Wide-field fundus image from infant ROP screening.
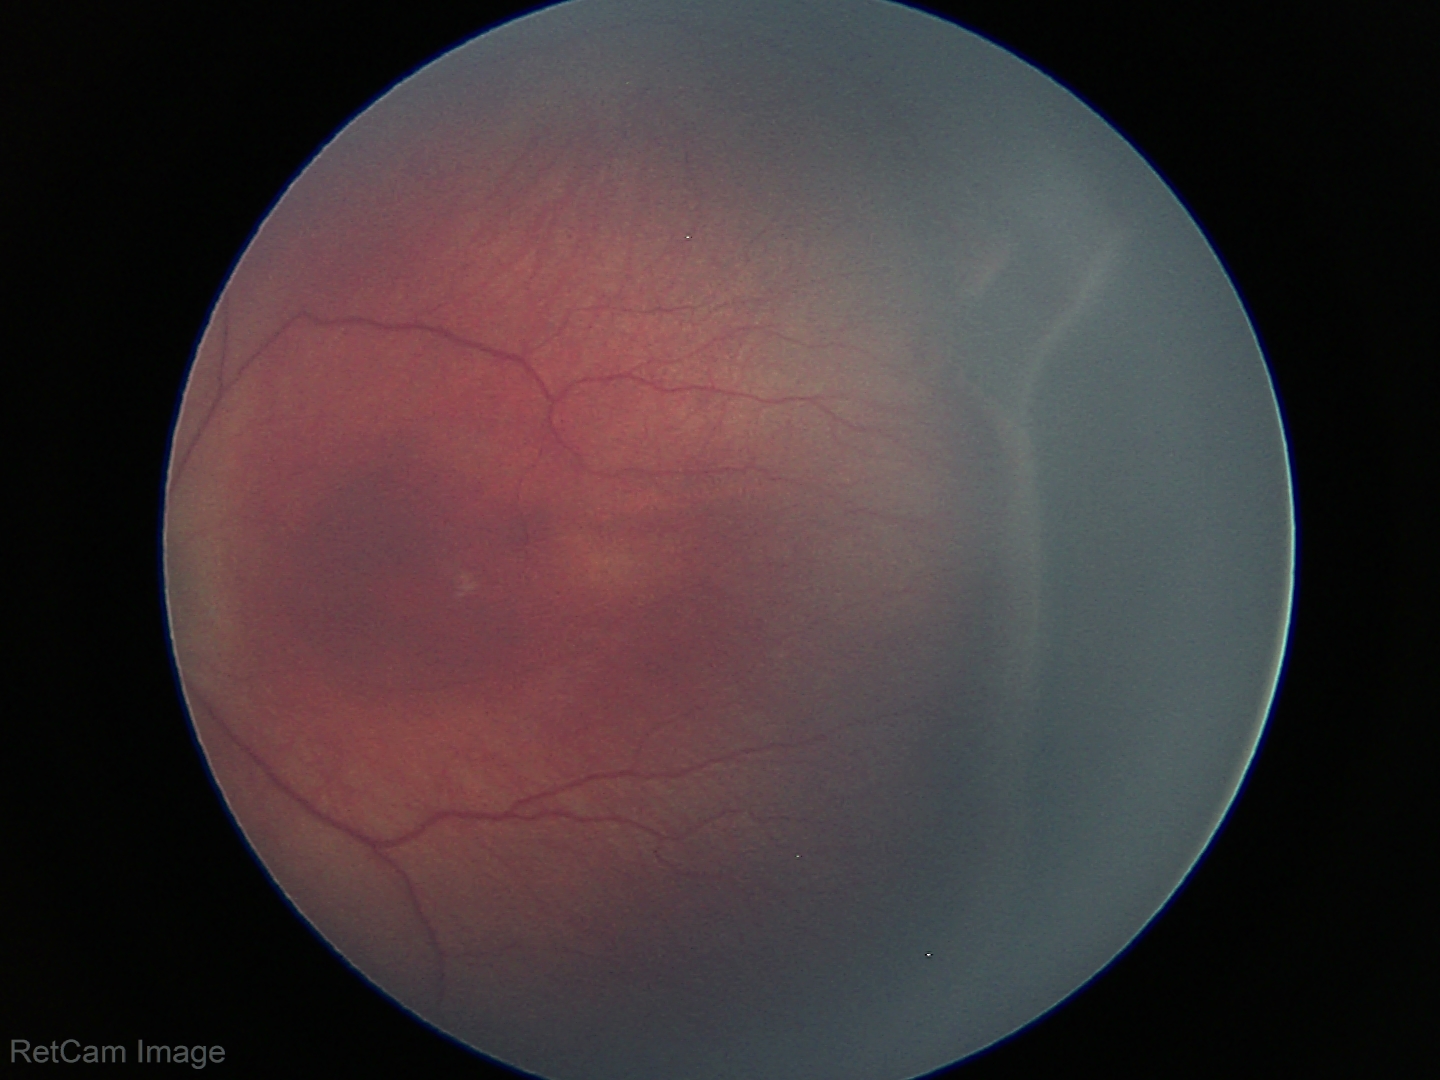

Q: What is the screening diagnosis?
A: retinopathy of prematurity stage 3 — ridge with extraretinal fibrovascular proliferation
Q: Plus disease status?
A: no plus disease